Wide-field fundus photograph of an infant; 1240 x 1240 pixels.
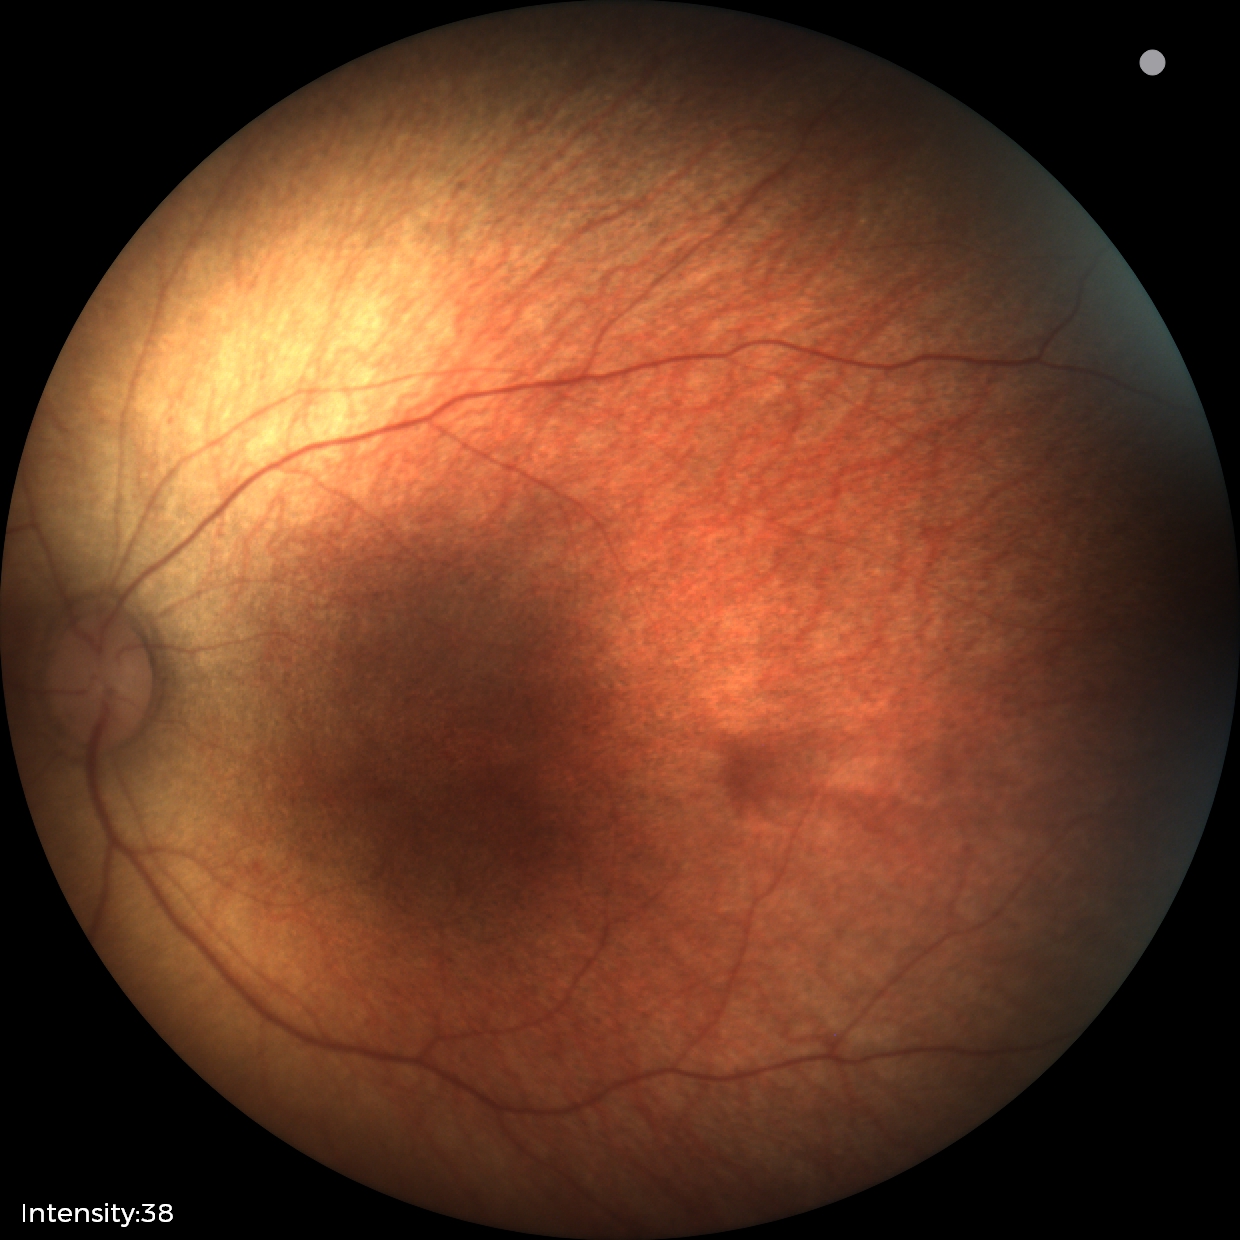
Q: What is the diagnosis from this examination?
A: normal retinal appearance